2102x1736px, color fundus image.
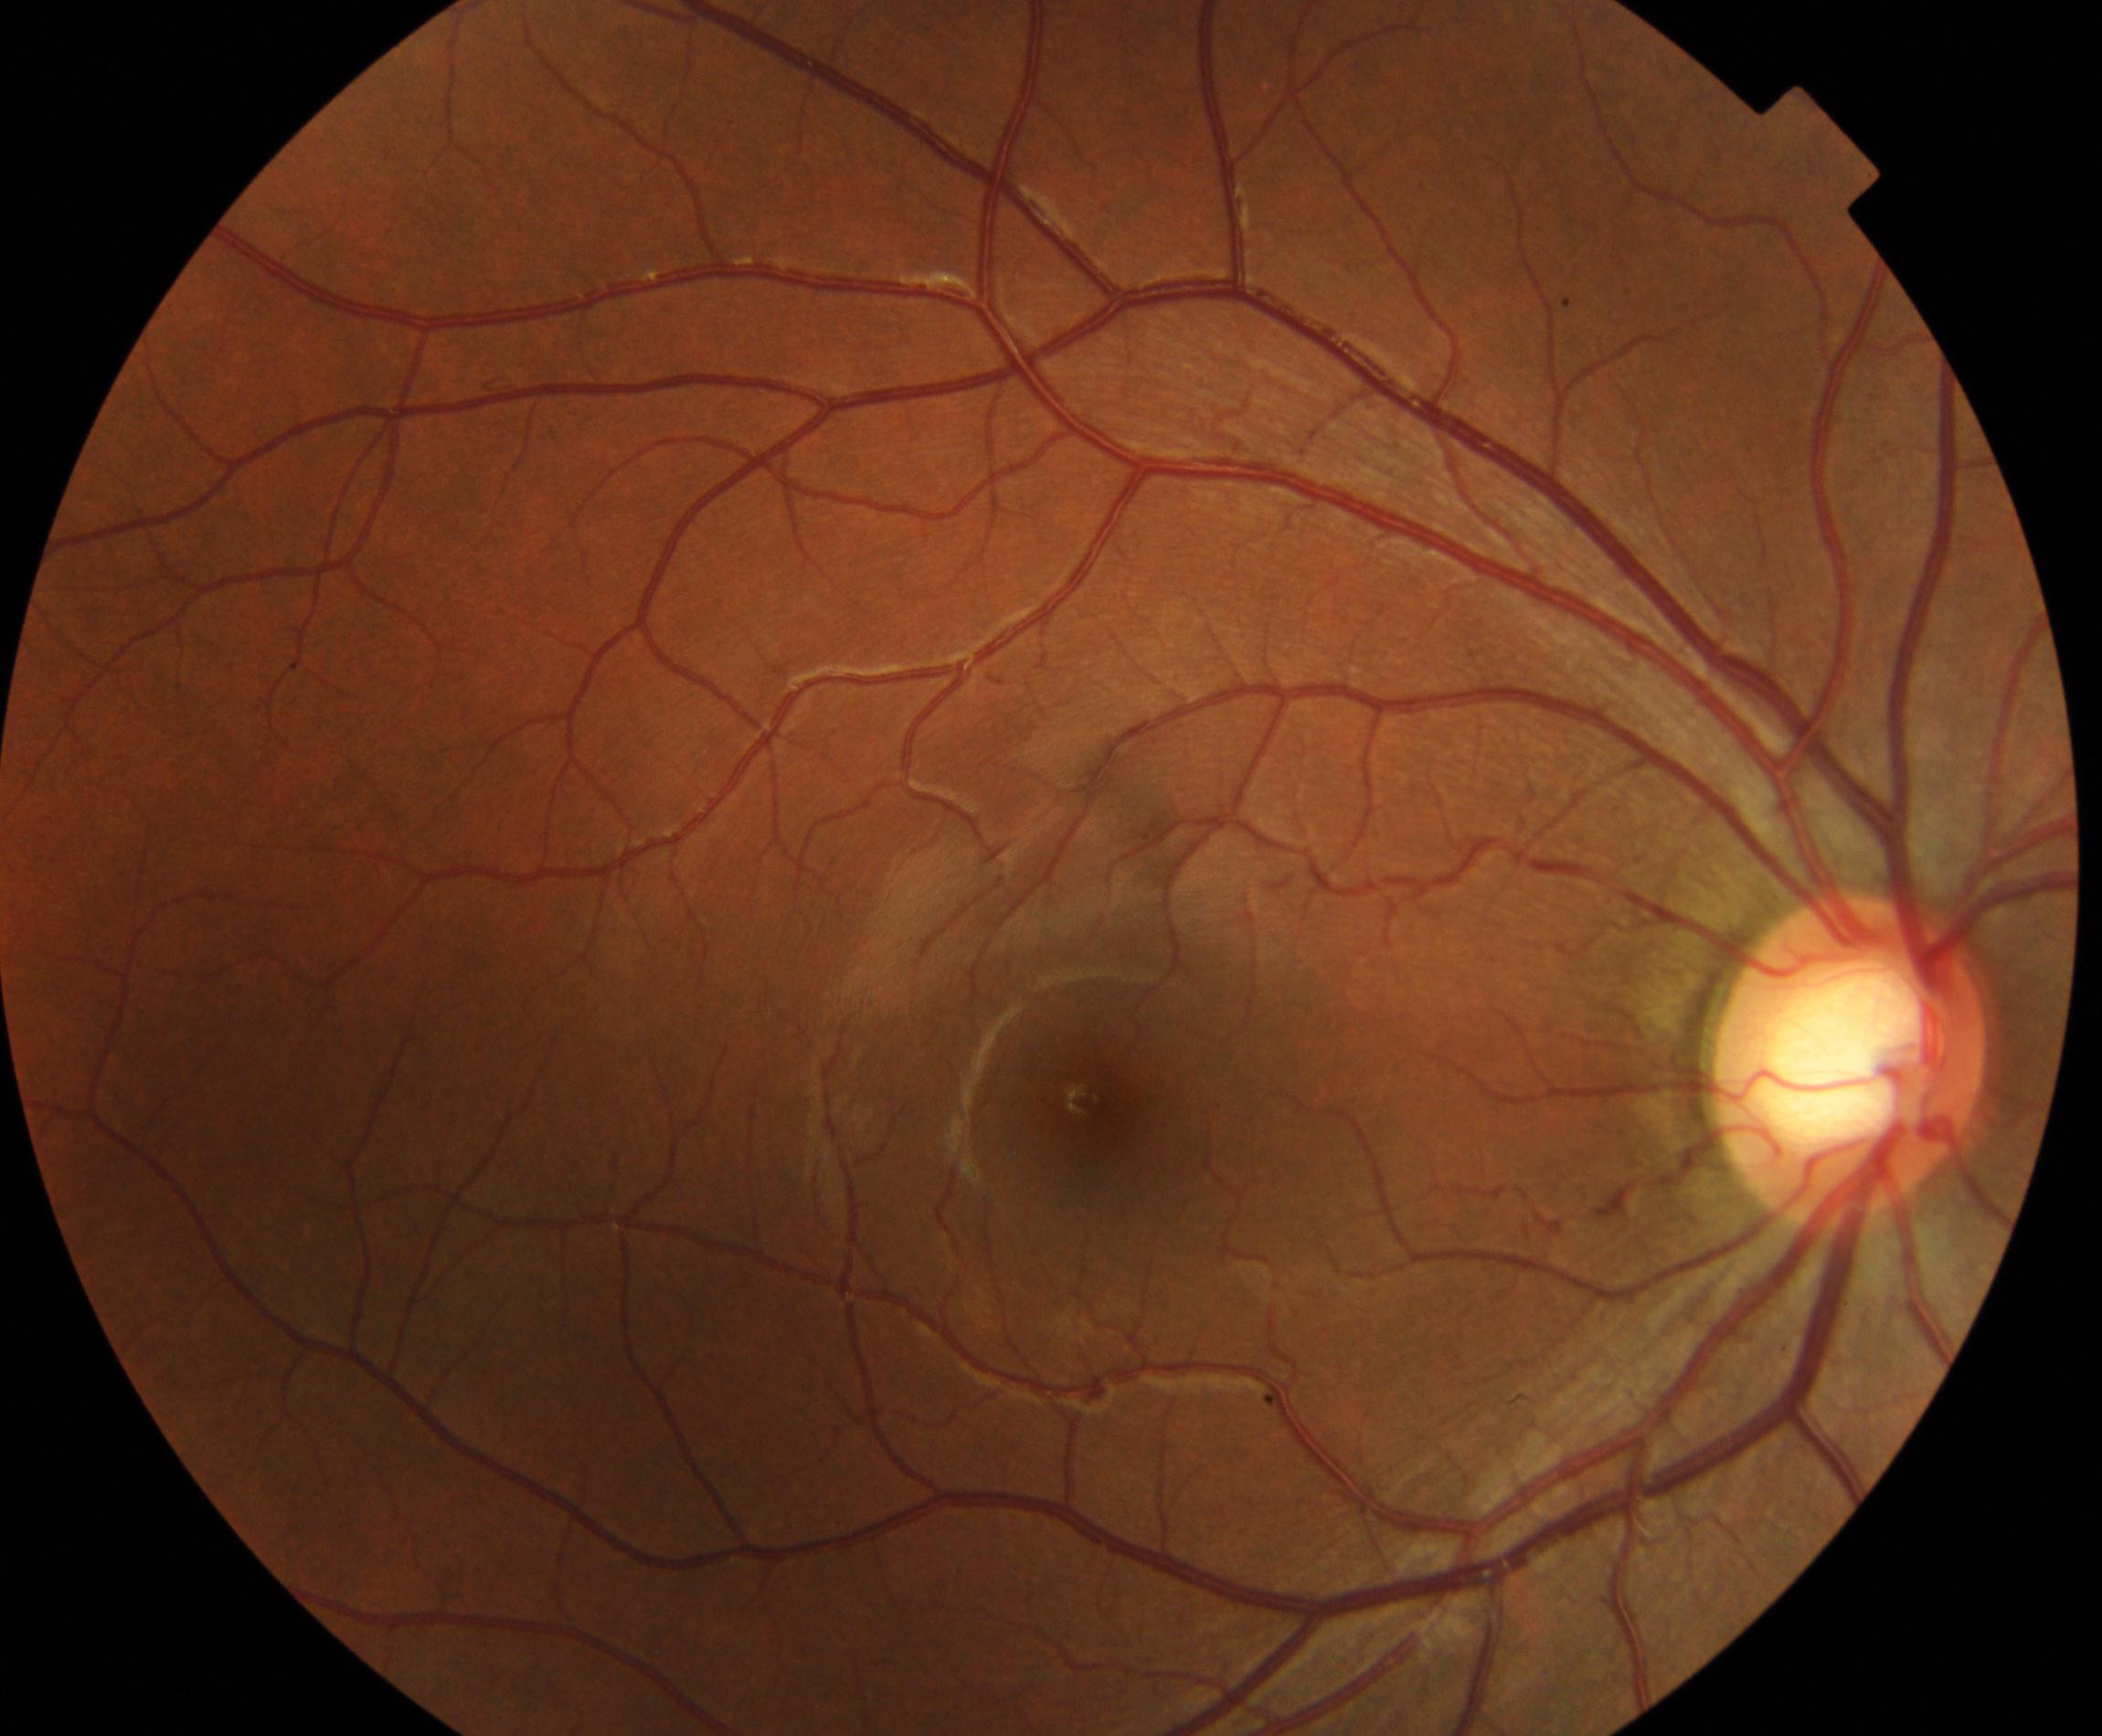 Classification: large optic cup.